1240x1240px; wide-field fundus photograph of an infant — 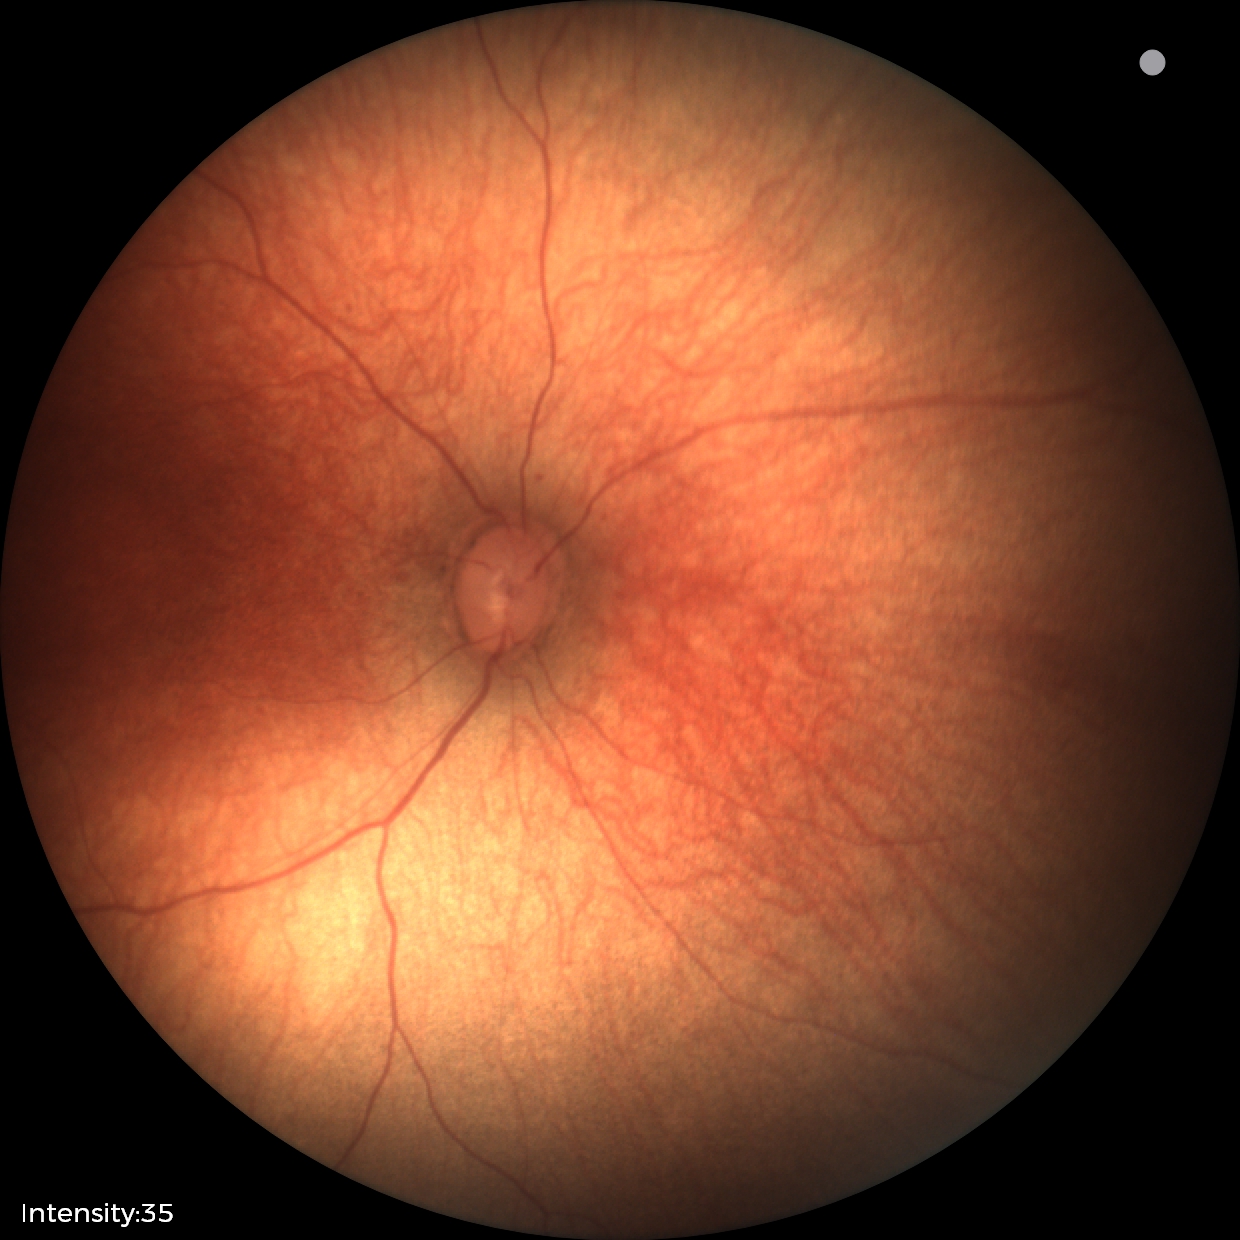

Examination with physiological retinal findings.